Nonmydriatic fundus photograph; camera: NIDEK AFC-230; image size 848x848; 45° FOV; posterior pole photograph — 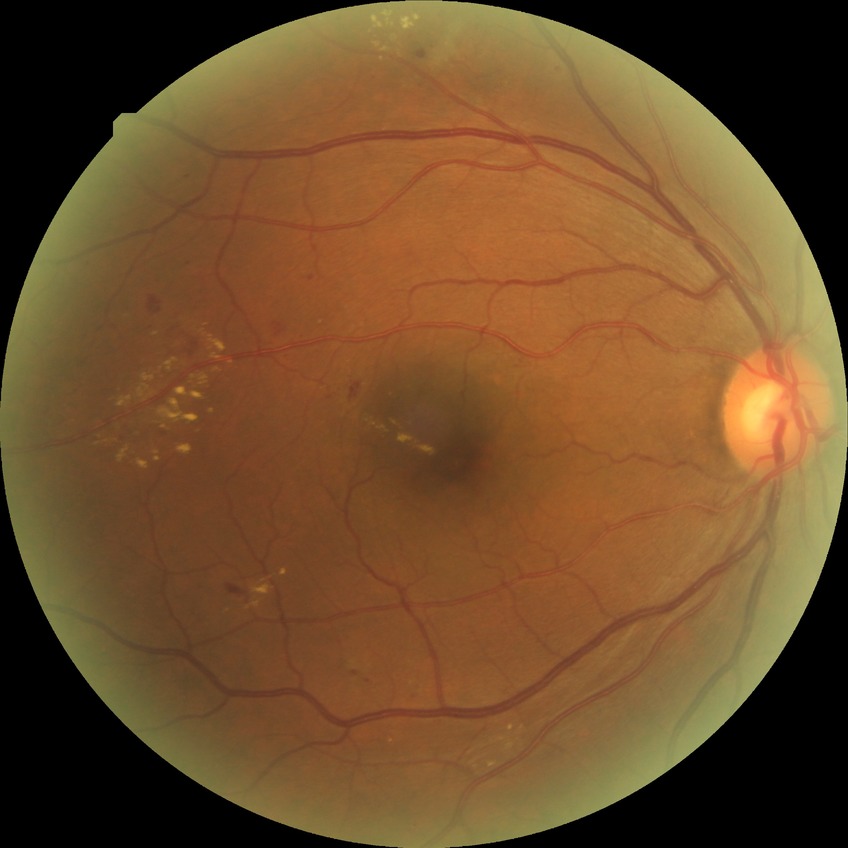

DR grade: SDR.